Wide-field contact fundus photograph of an infant · camera: Natus RetCam Envision (130° FOV):
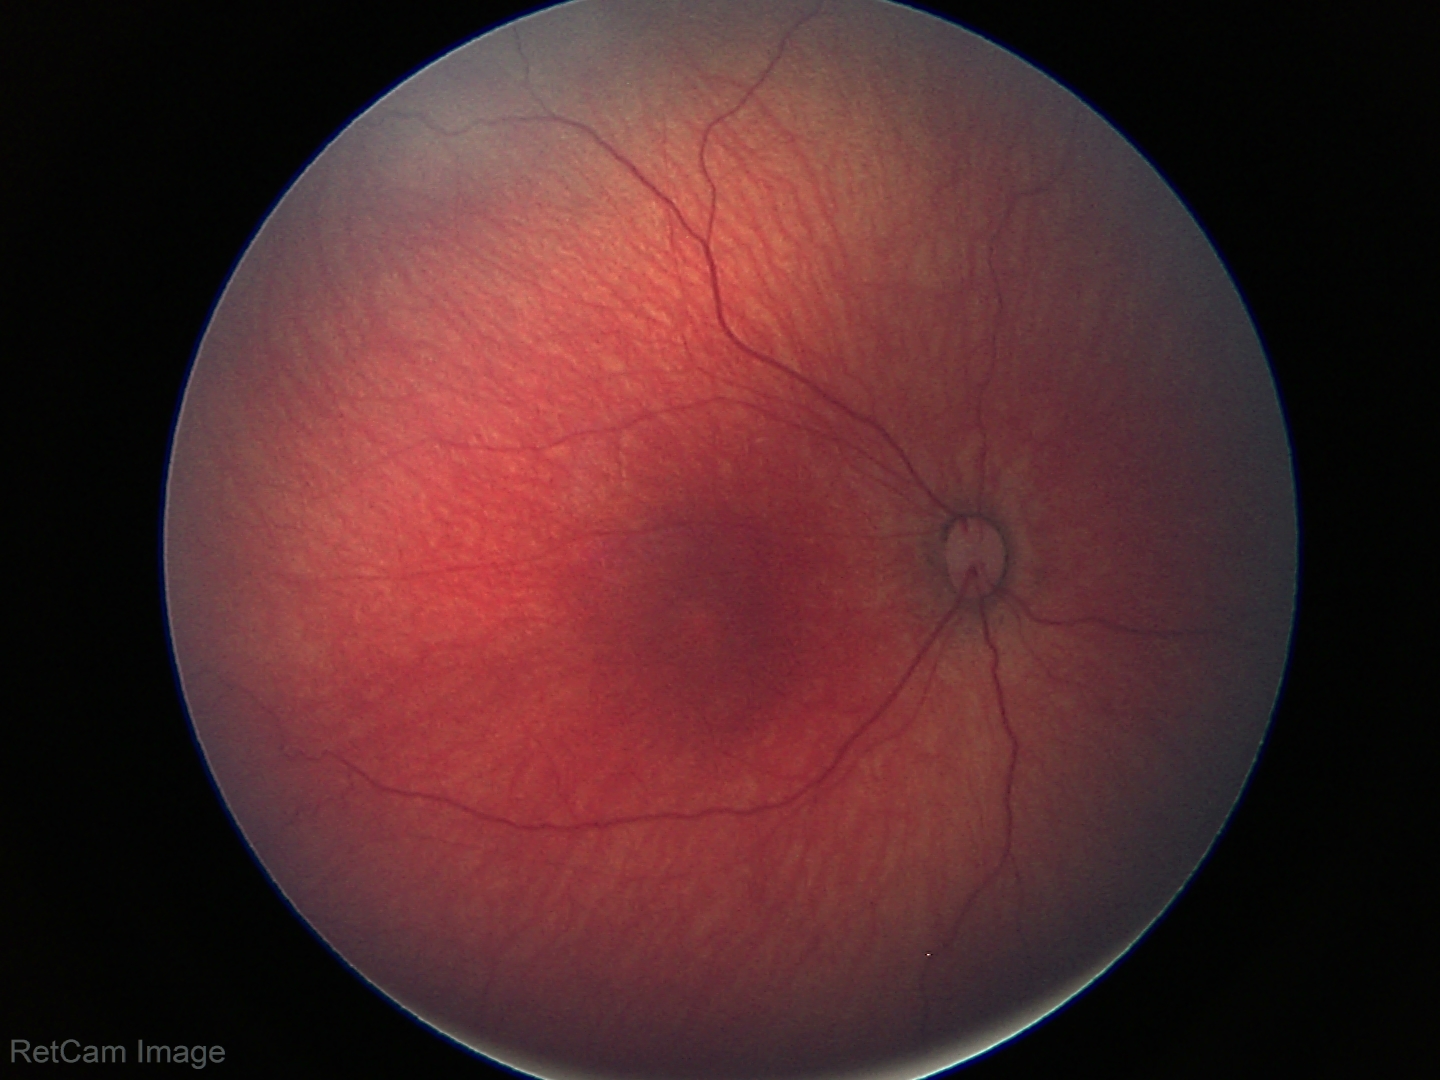
Normal screening examination.